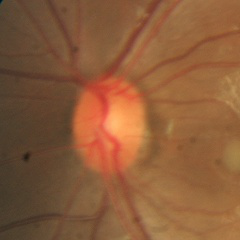 Fundus image with findings of no glaucomatous changes.